1659x2212: 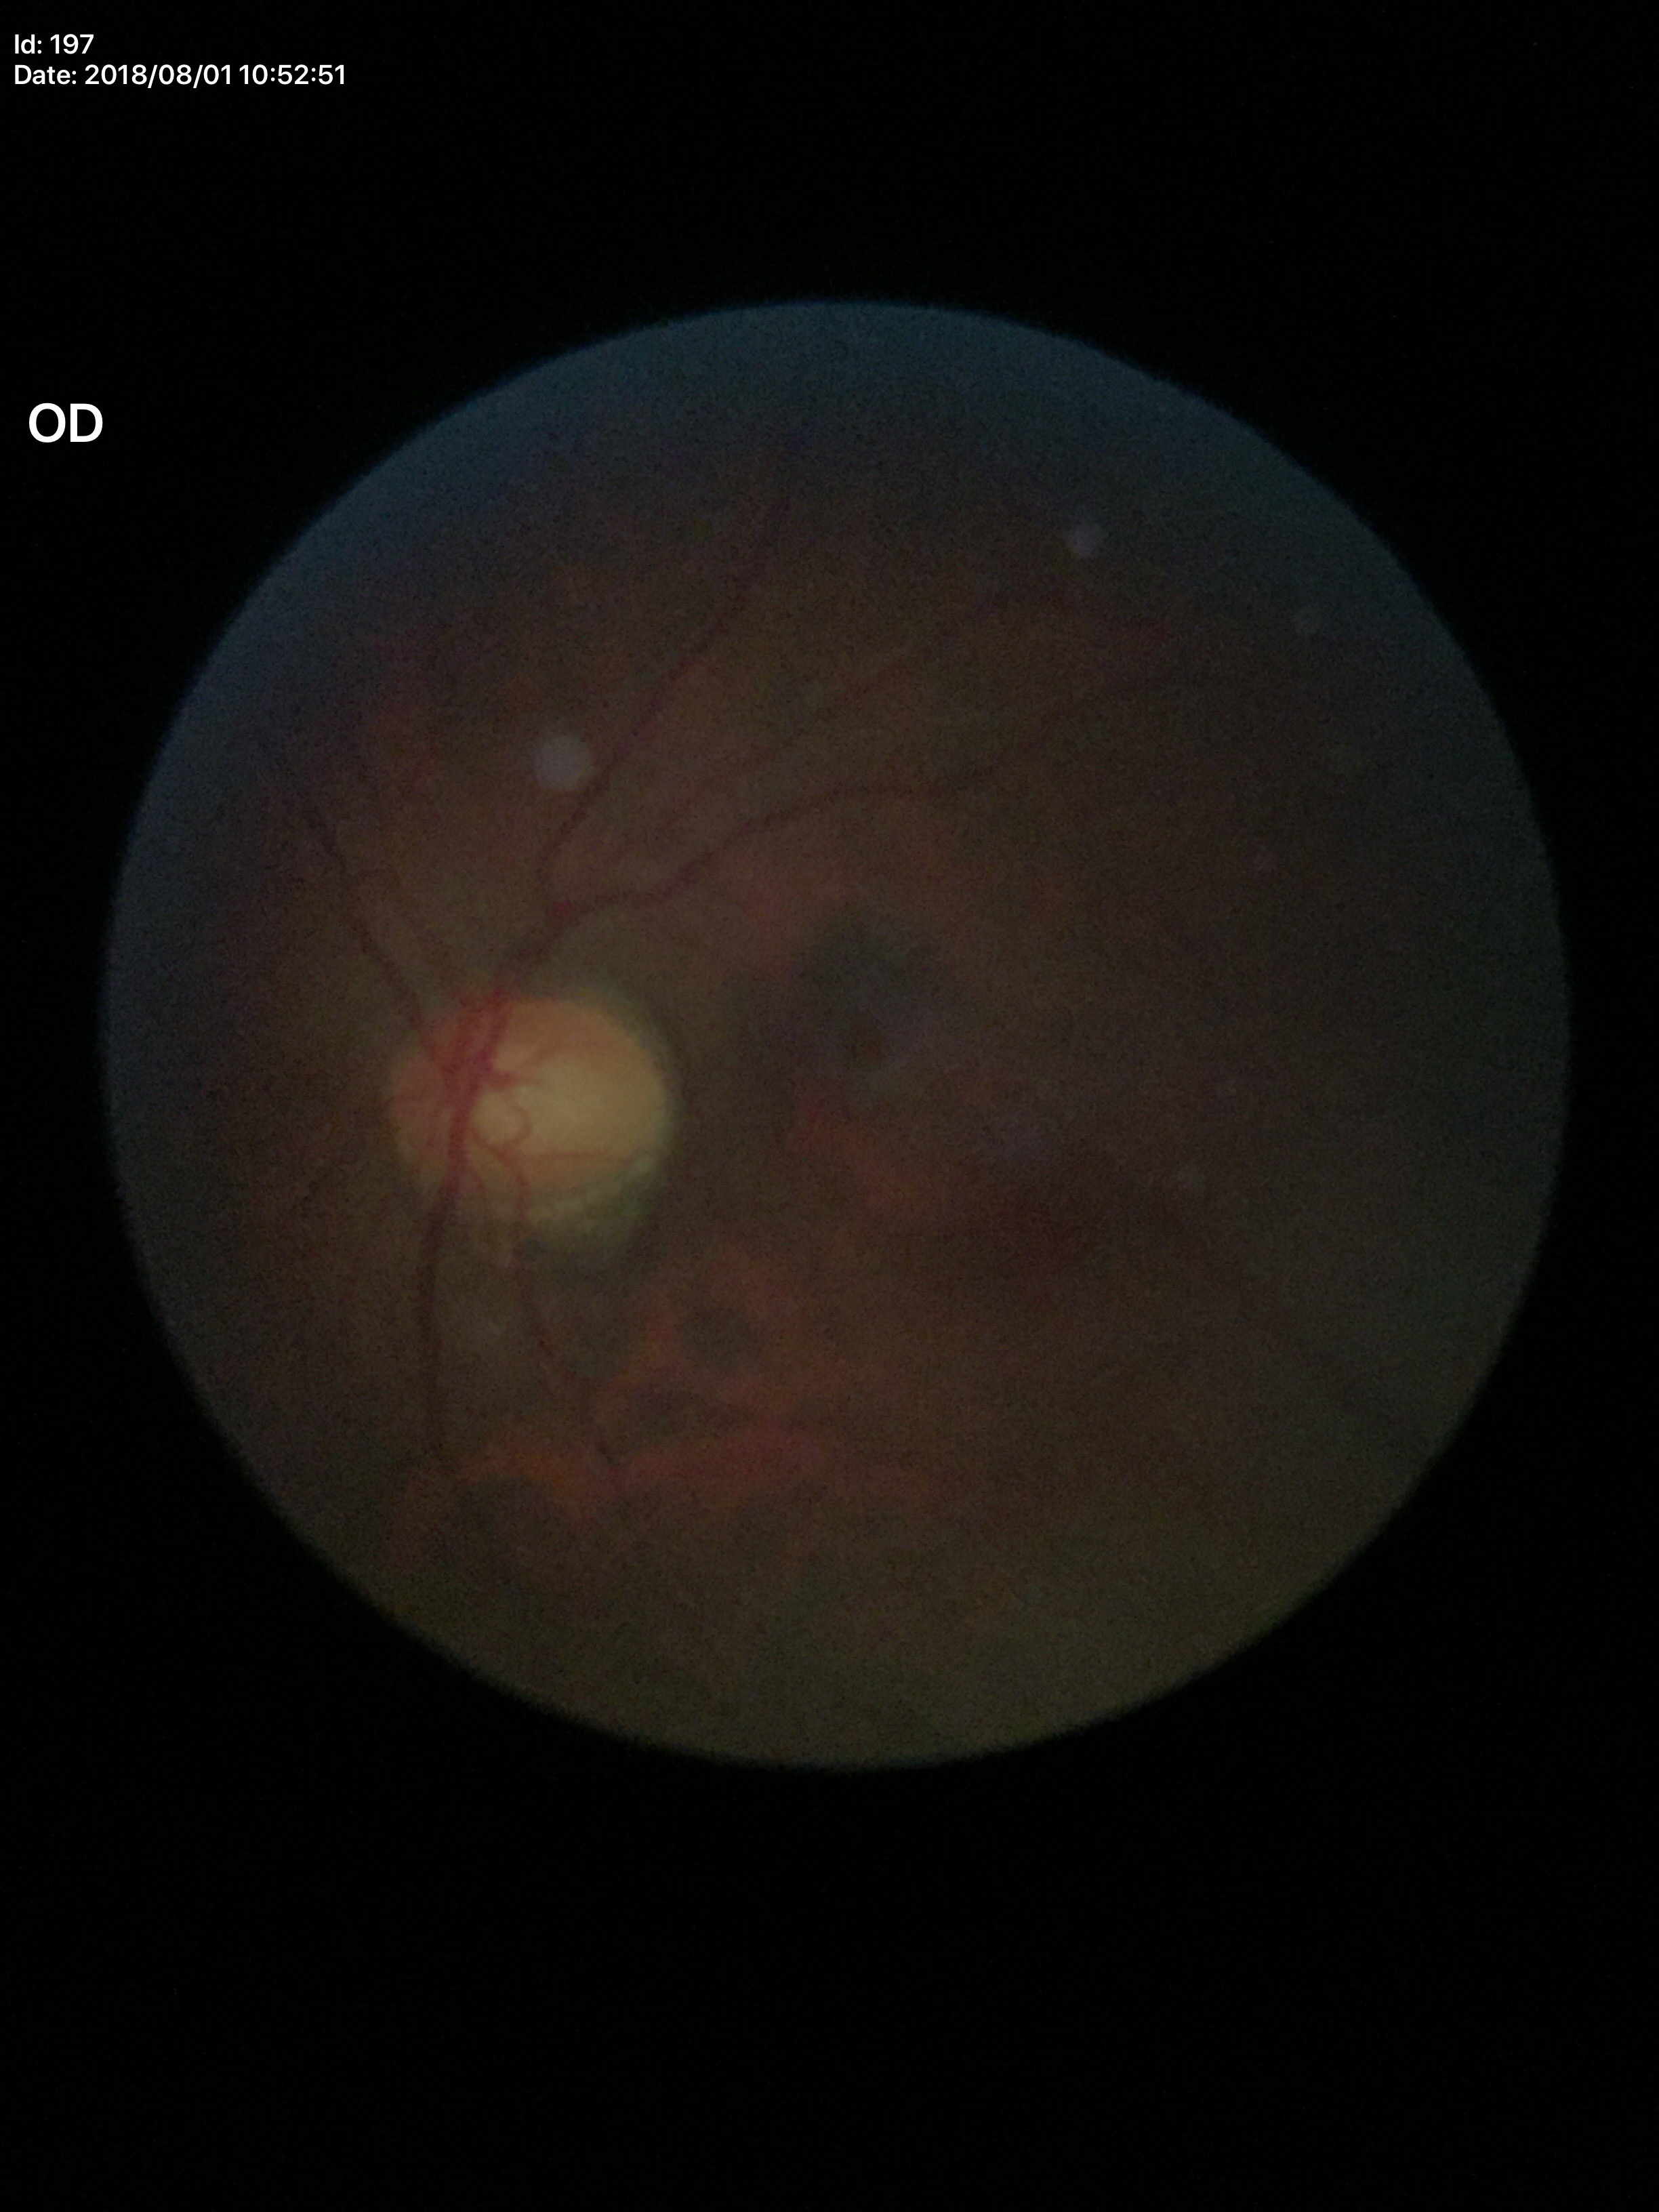 Not suspicious for glaucoma.
Vertical cup-to-disc ratio (VCDR): 0.57.
Horizontal cup-disc ratio (HCDR): 0.62.